Color fundus photograph — 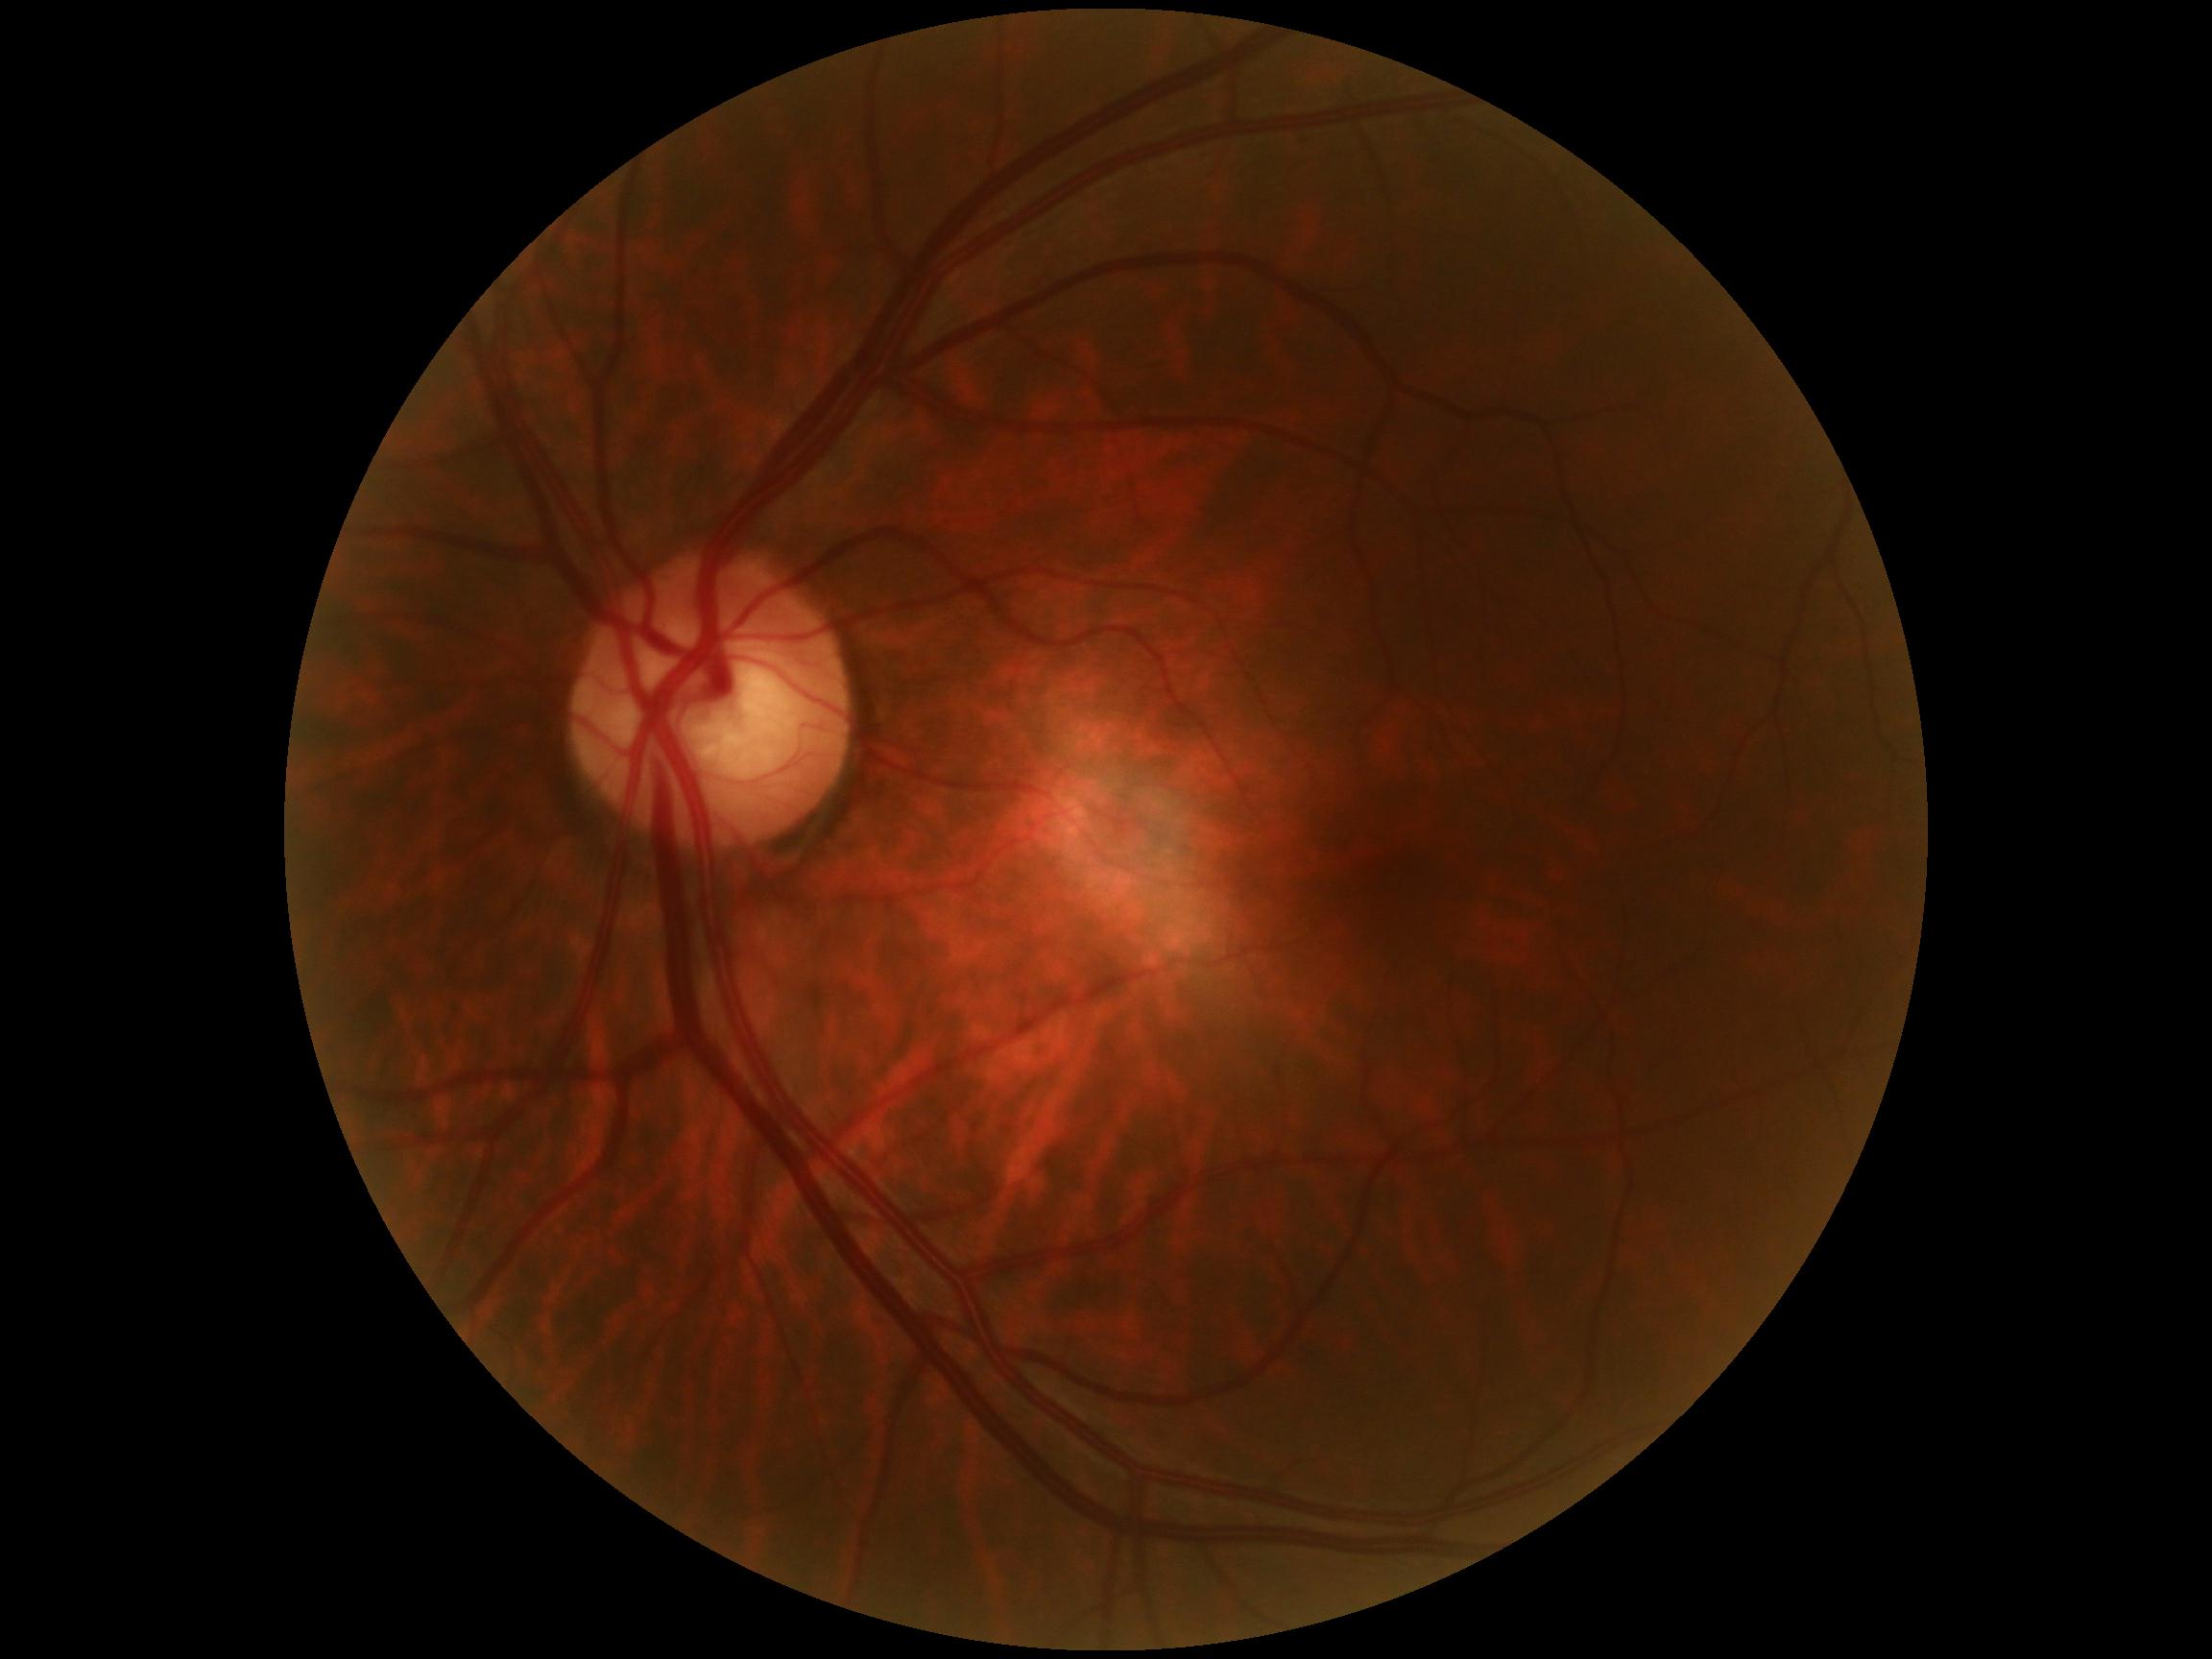
– DR impression: no DR findings
– DR: 0